Image size 2184x1690
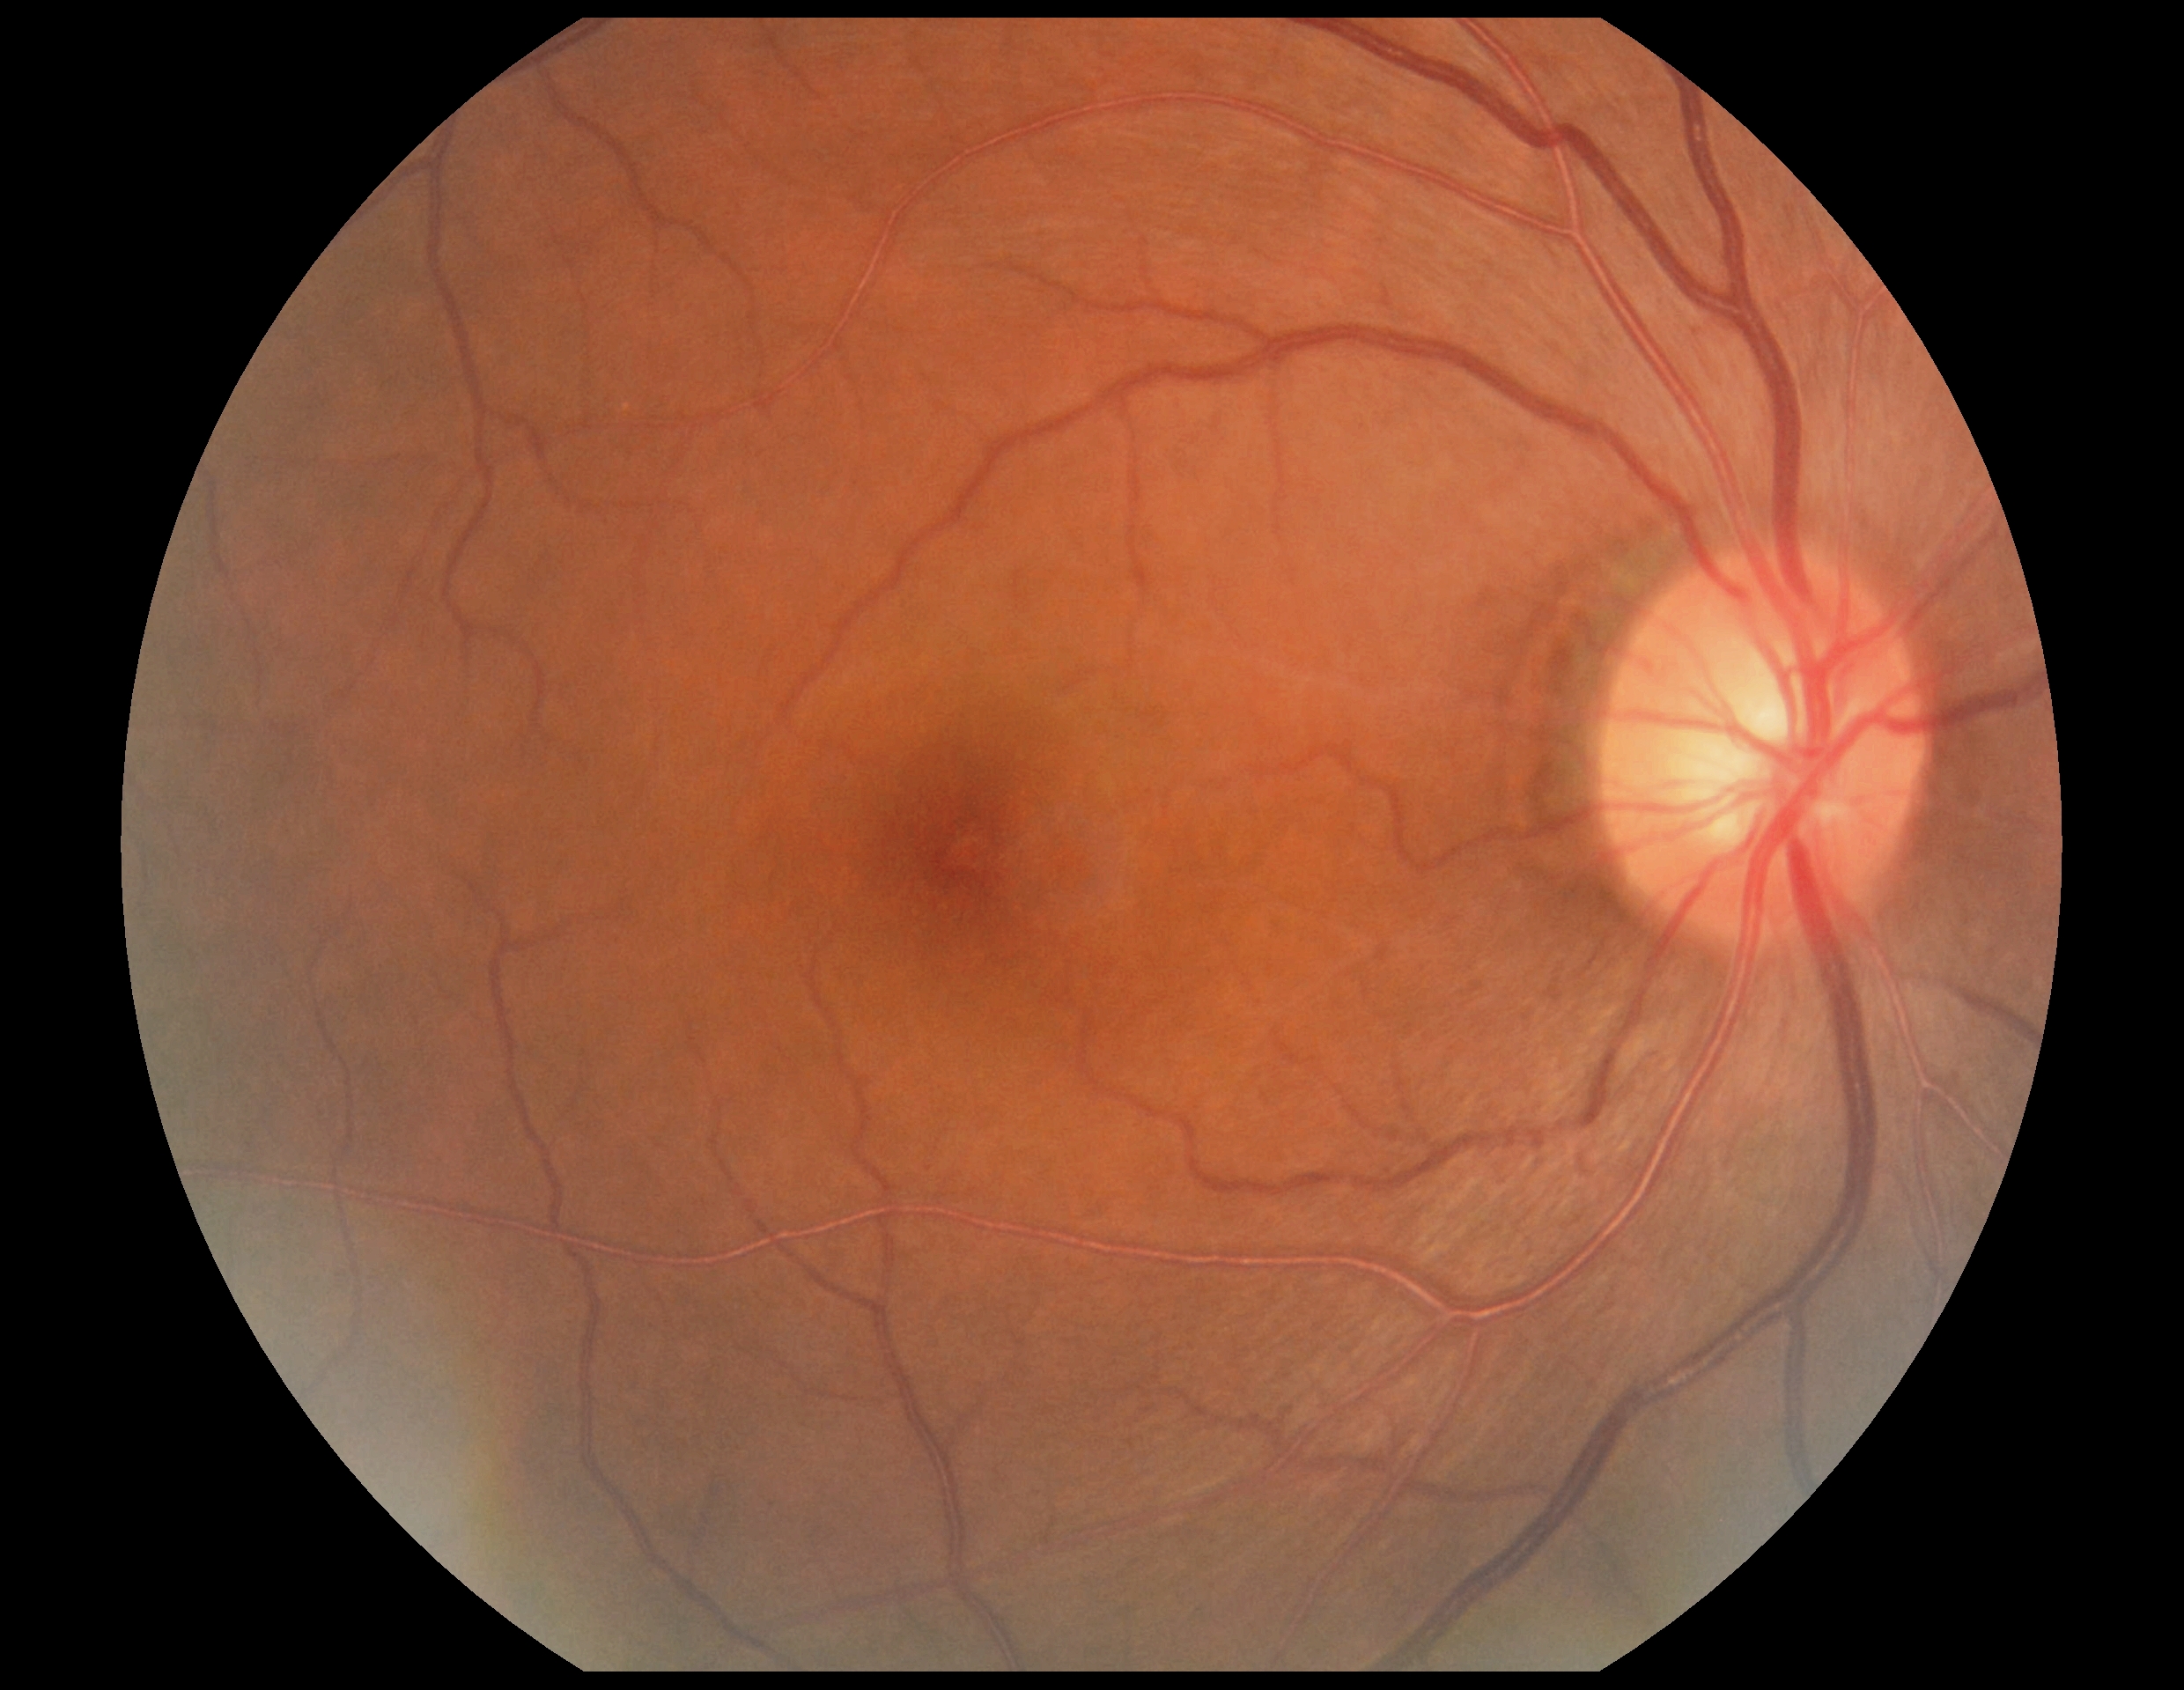 diabetic retinopathy (DR) = grade 0 (no apparent retinopathy) — no visible signs of diabetic retinopathy.